FOV: 45 degrees. Color fundus image. 2352 x 1568 pixels — 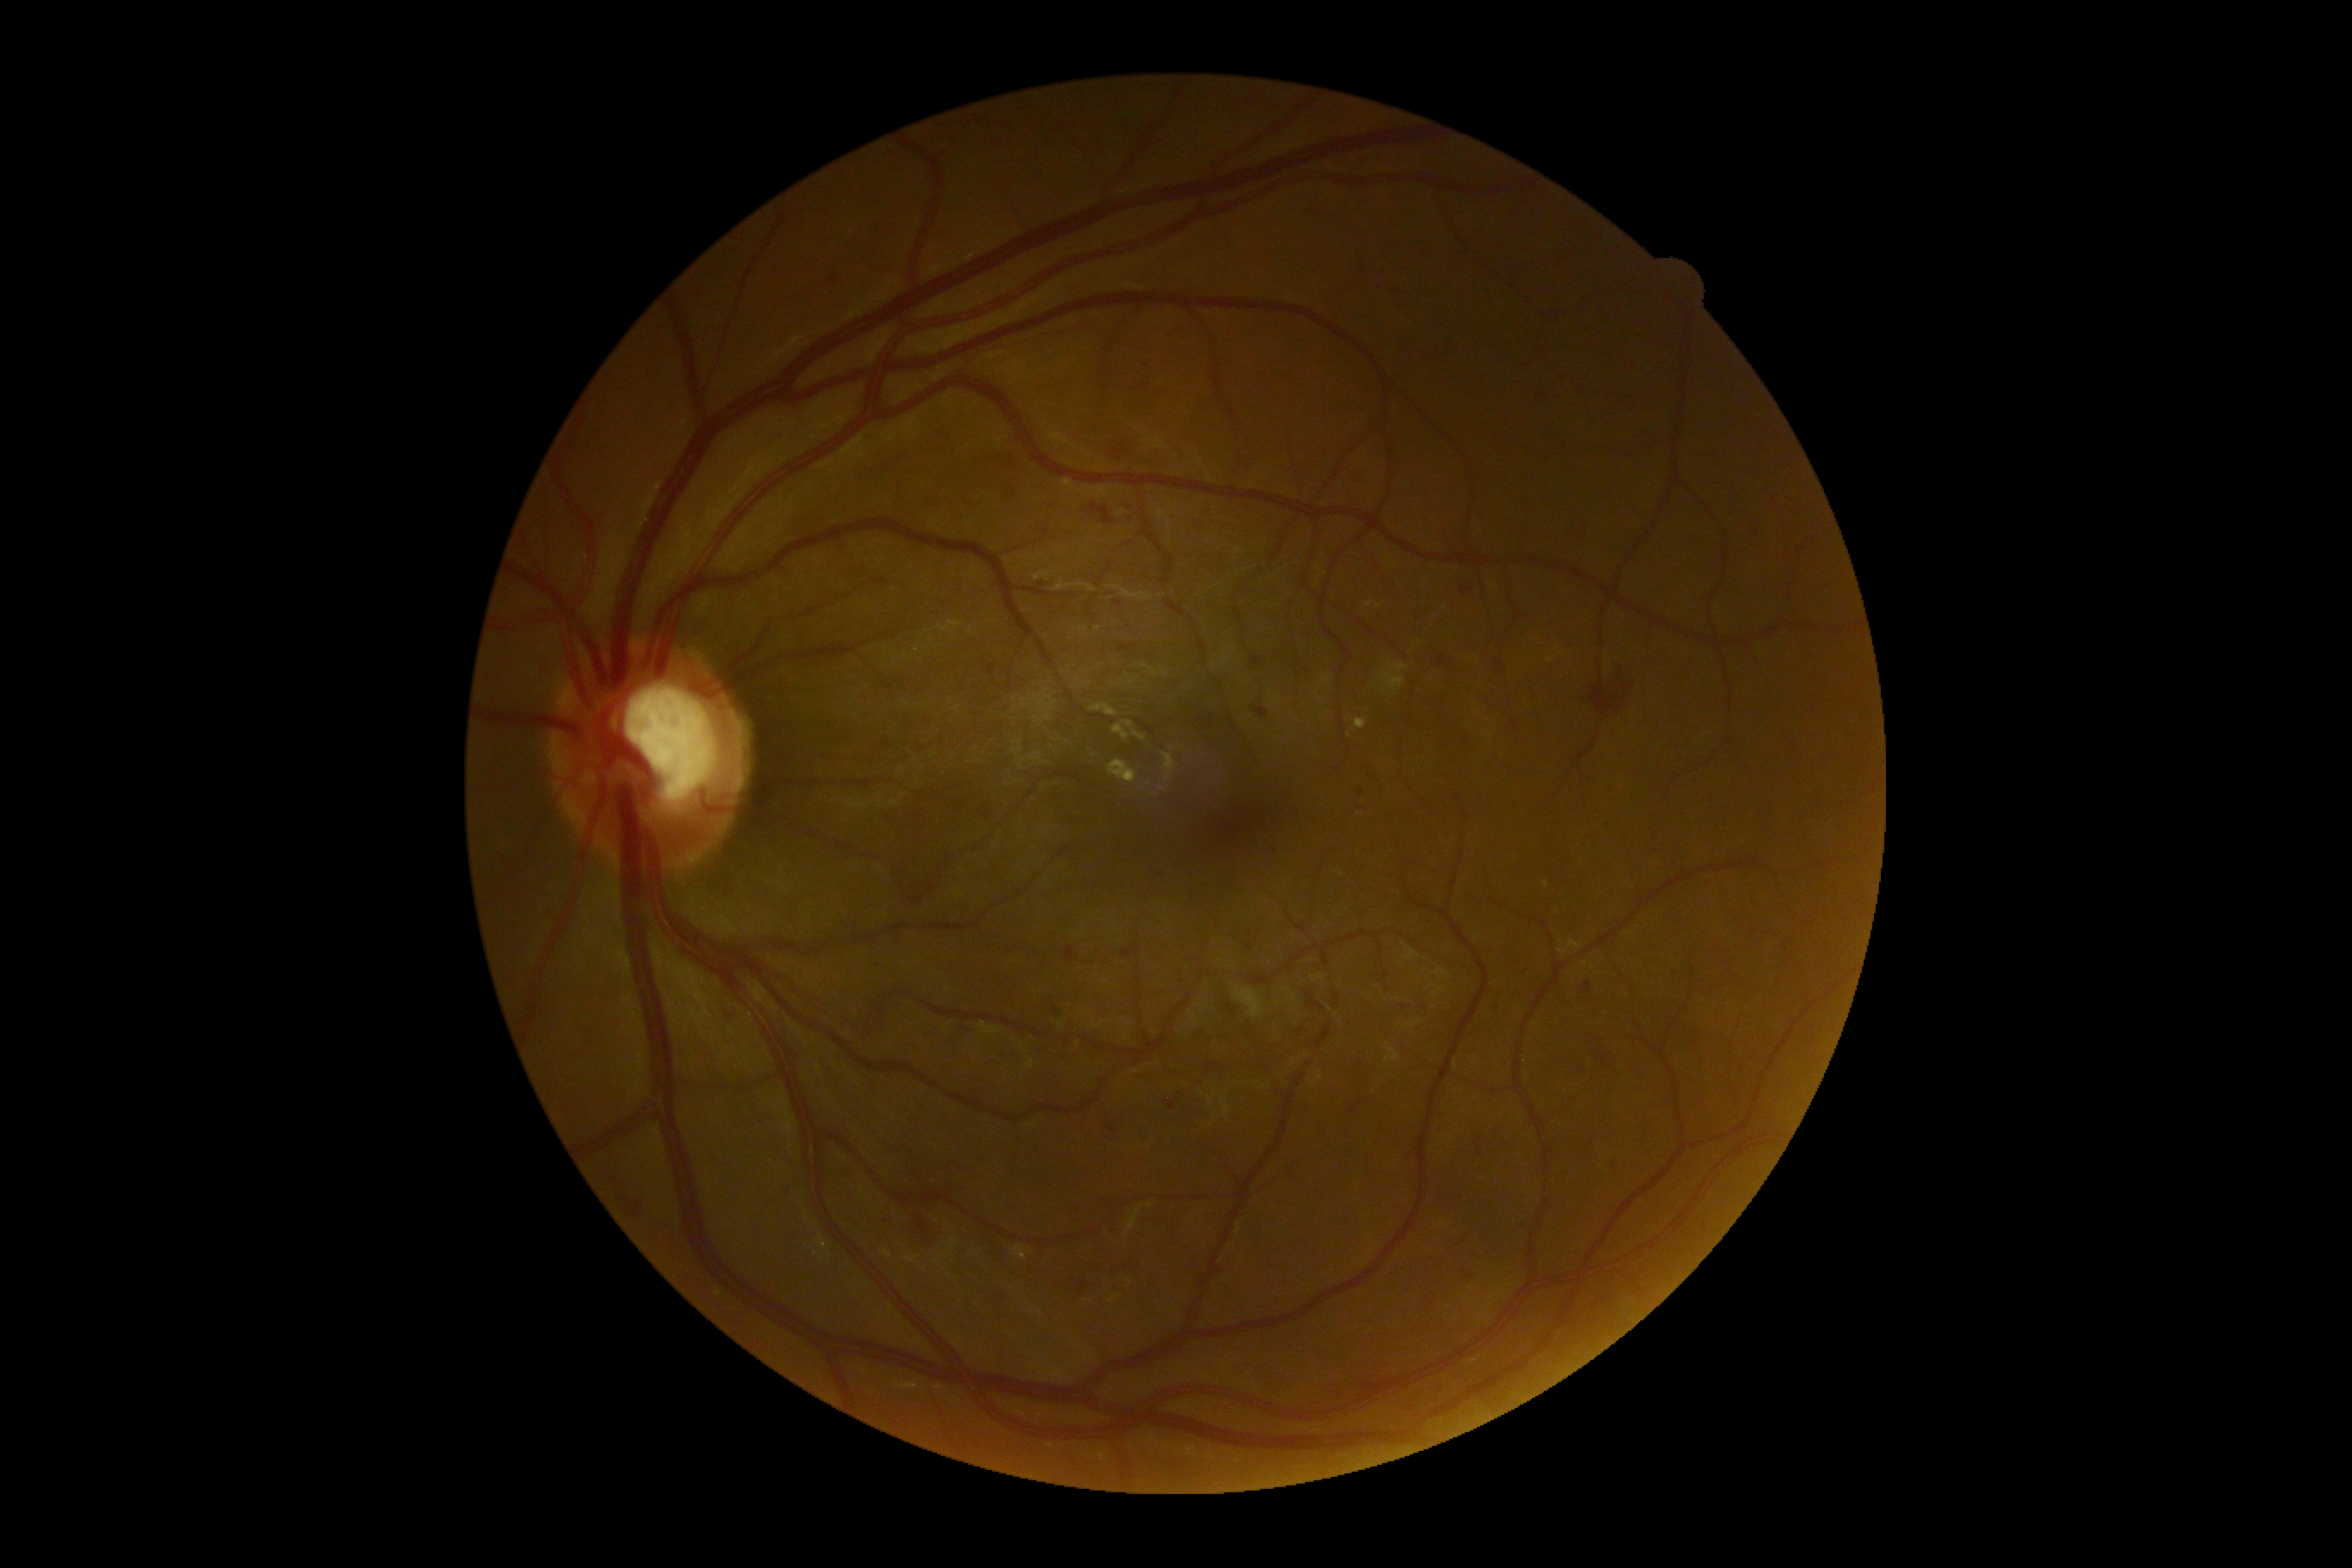
<lesions partial="true">
  <dr_grade>2</dr_grade>
  <he partial="true"><region>1084, 506, 1117, 525</region>, <region>1591, 665, 1634, 723</region>, <region>1419, 517, 1435, 529</region>, <region>879, 1213, 897, 1230</region>, <region>1253, 706, 1270, 721</region>, <region>1108, 1129, 1117, 1134</region>, <region>1462, 585, 1473, 597</region>, <region>977, 809, 995, 823</region>, <region>721, 1001, 744, 1020</region>, <region>1507, 797, 1522, 811</region>, <region>1167, 1101, 1179, 1110</region>, <region>1602, 821, 1617, 831</region>, <region>1596, 1051, 1603, 1062</region></he>
  <he_small_approx>(1425; 1008), (1011; 497)</he_small_approx>
</lesions>